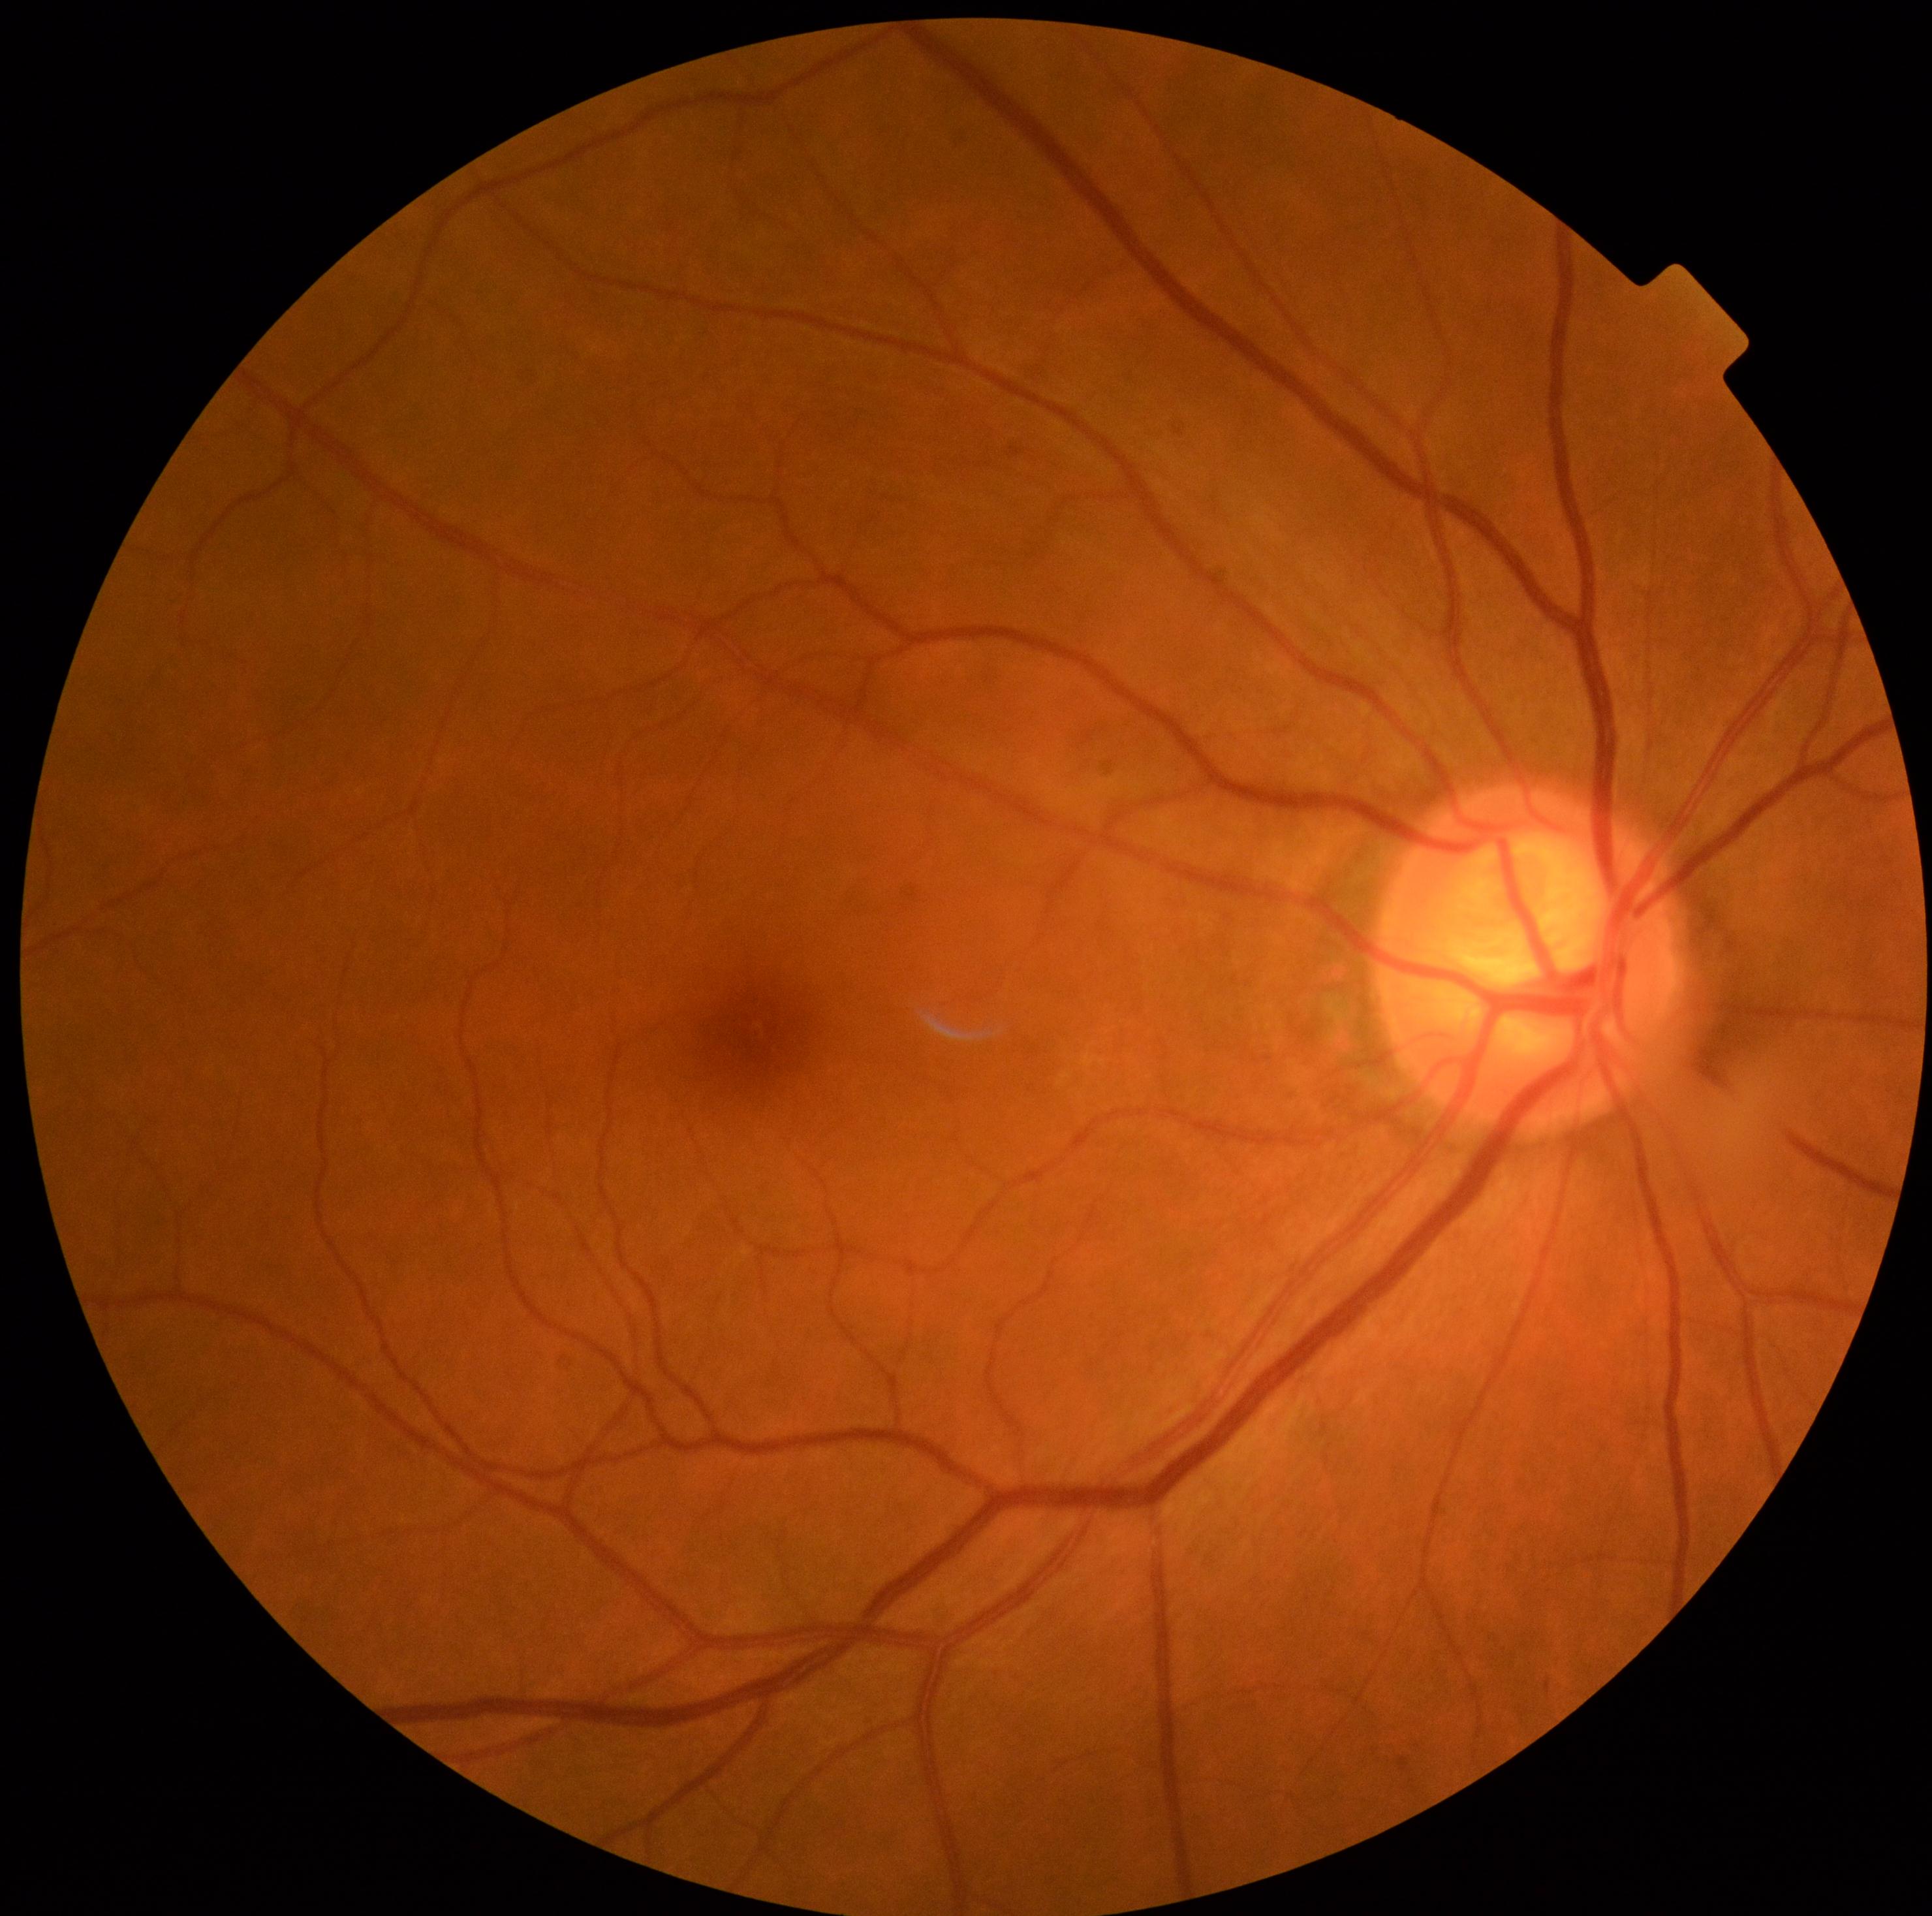
dr_grade: grade 0
dr_impression: no signs of DR